2352 by 1568 pixels; FOV: 45 degrees; fundus photo:
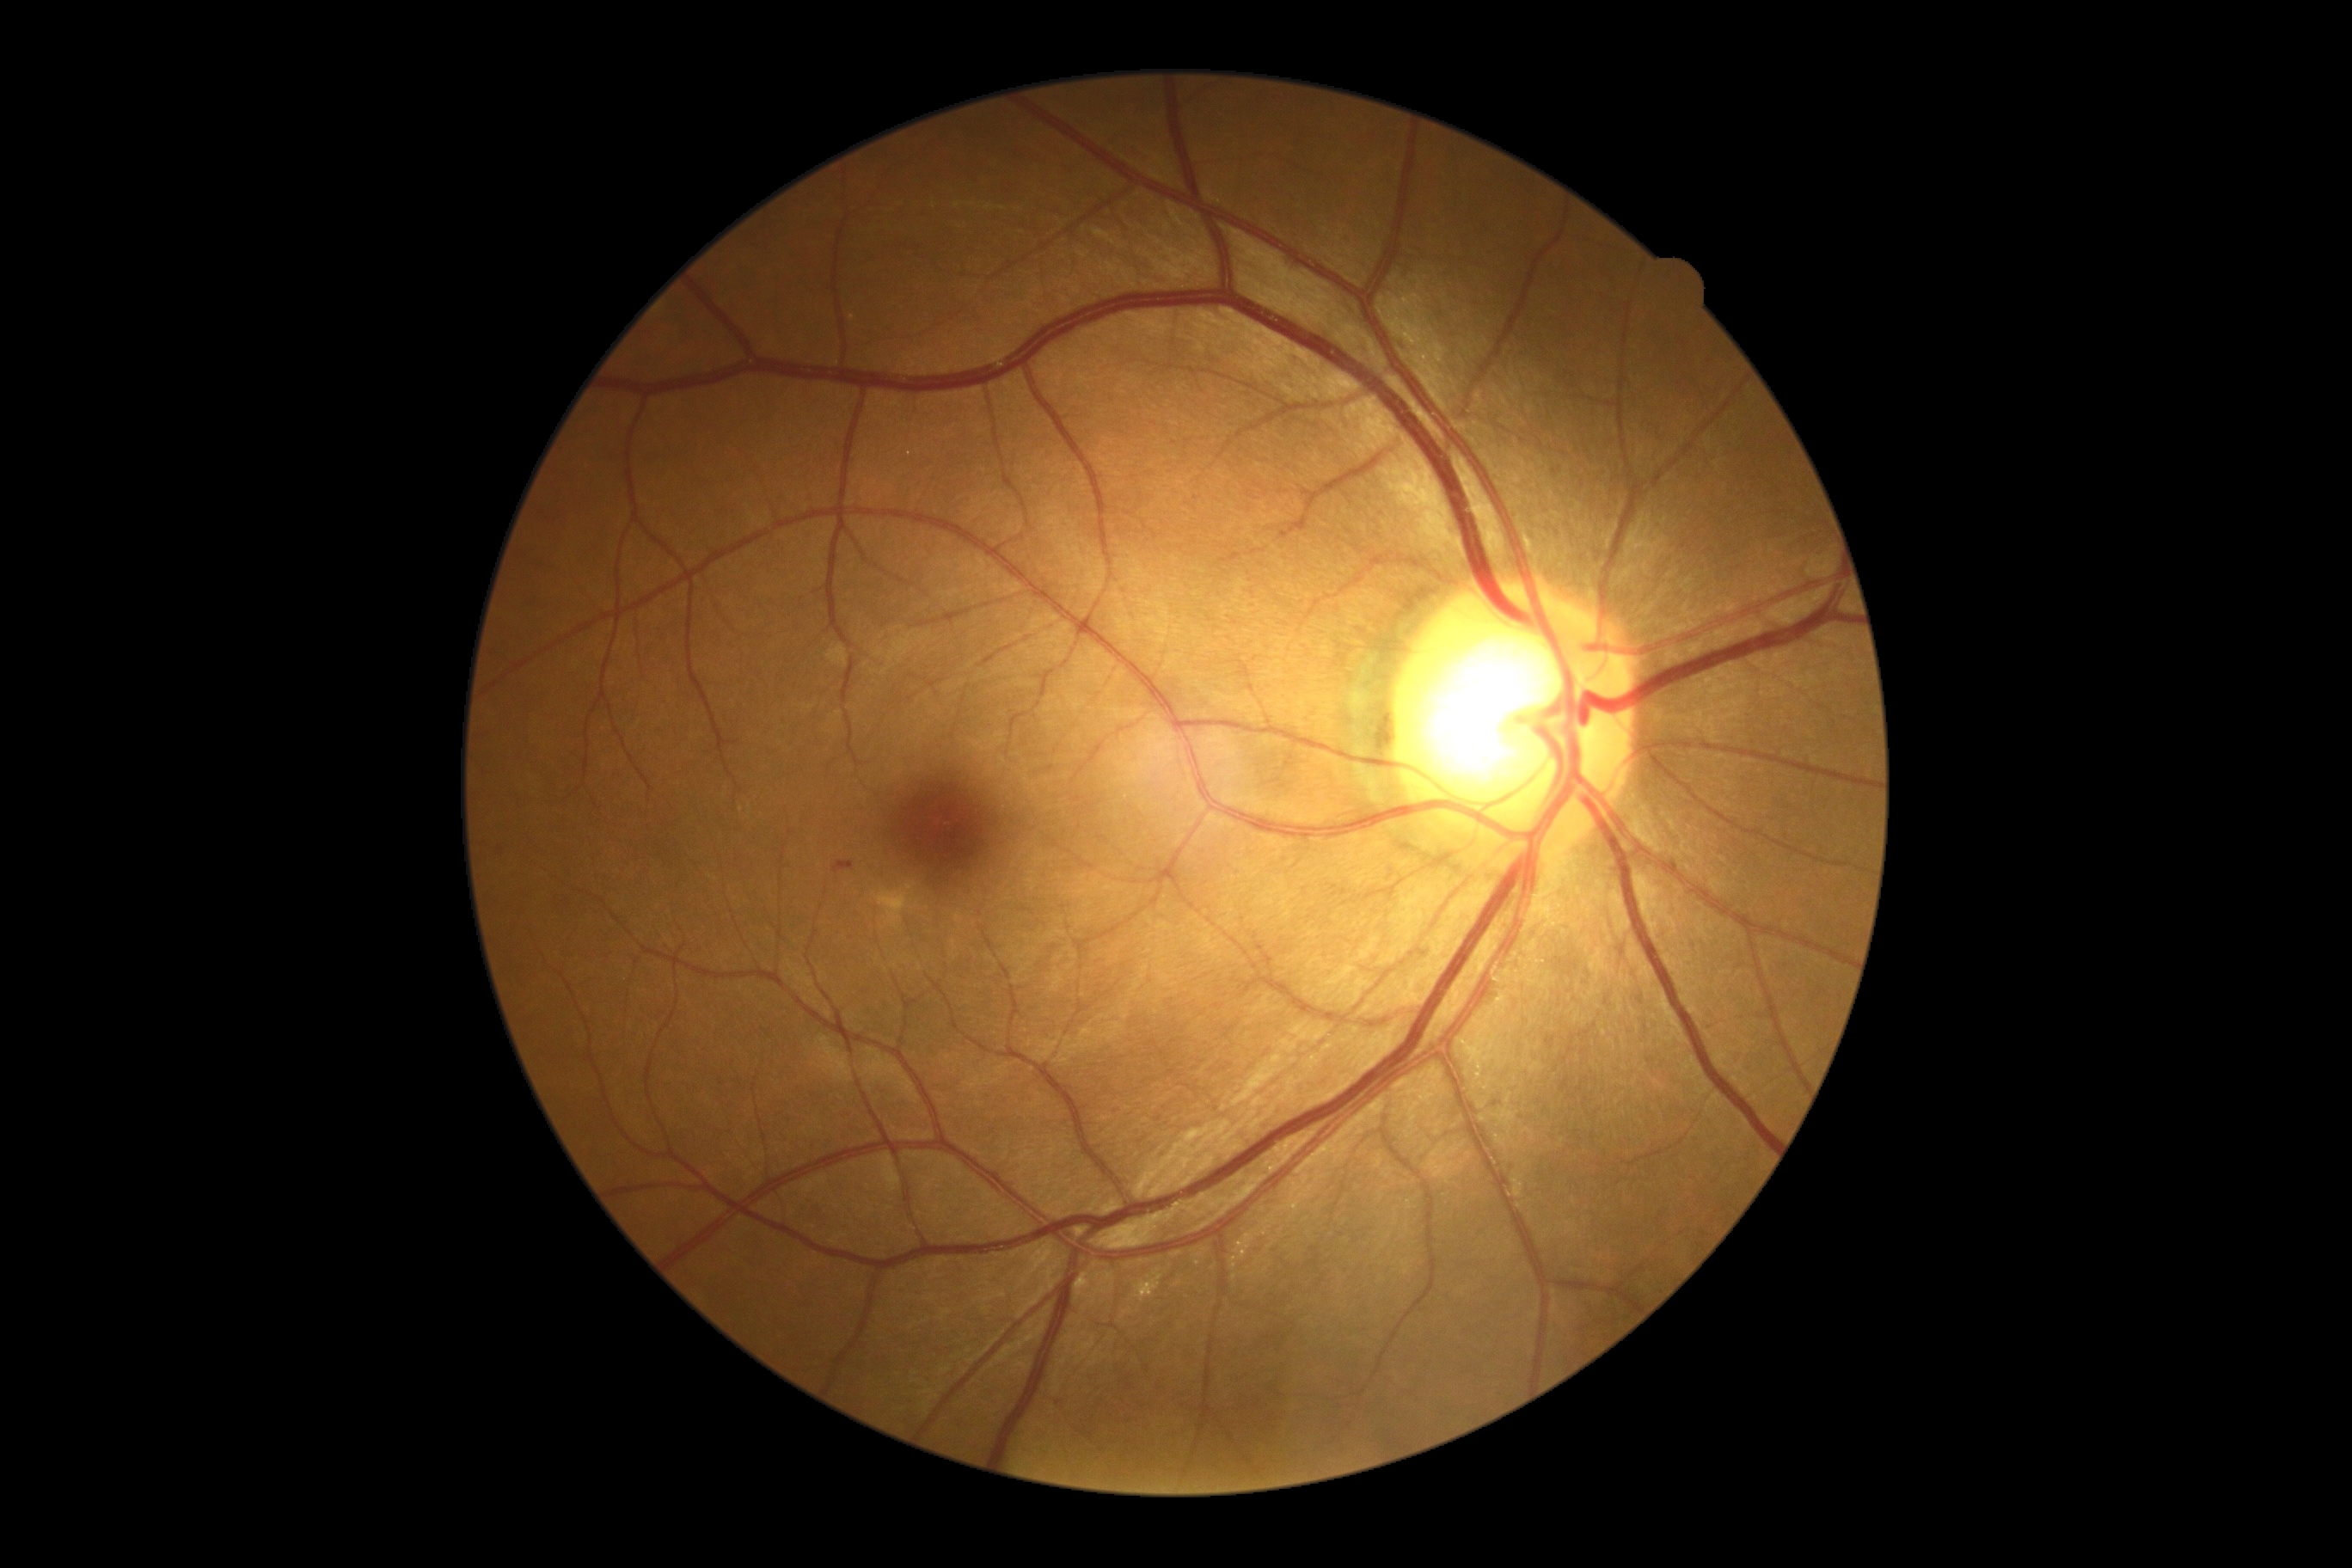 Annotations:
• retinopathy — moderate NPDR (grade 2)